Image size 2212x1659; color fundus image; FOV: 45 degrees:
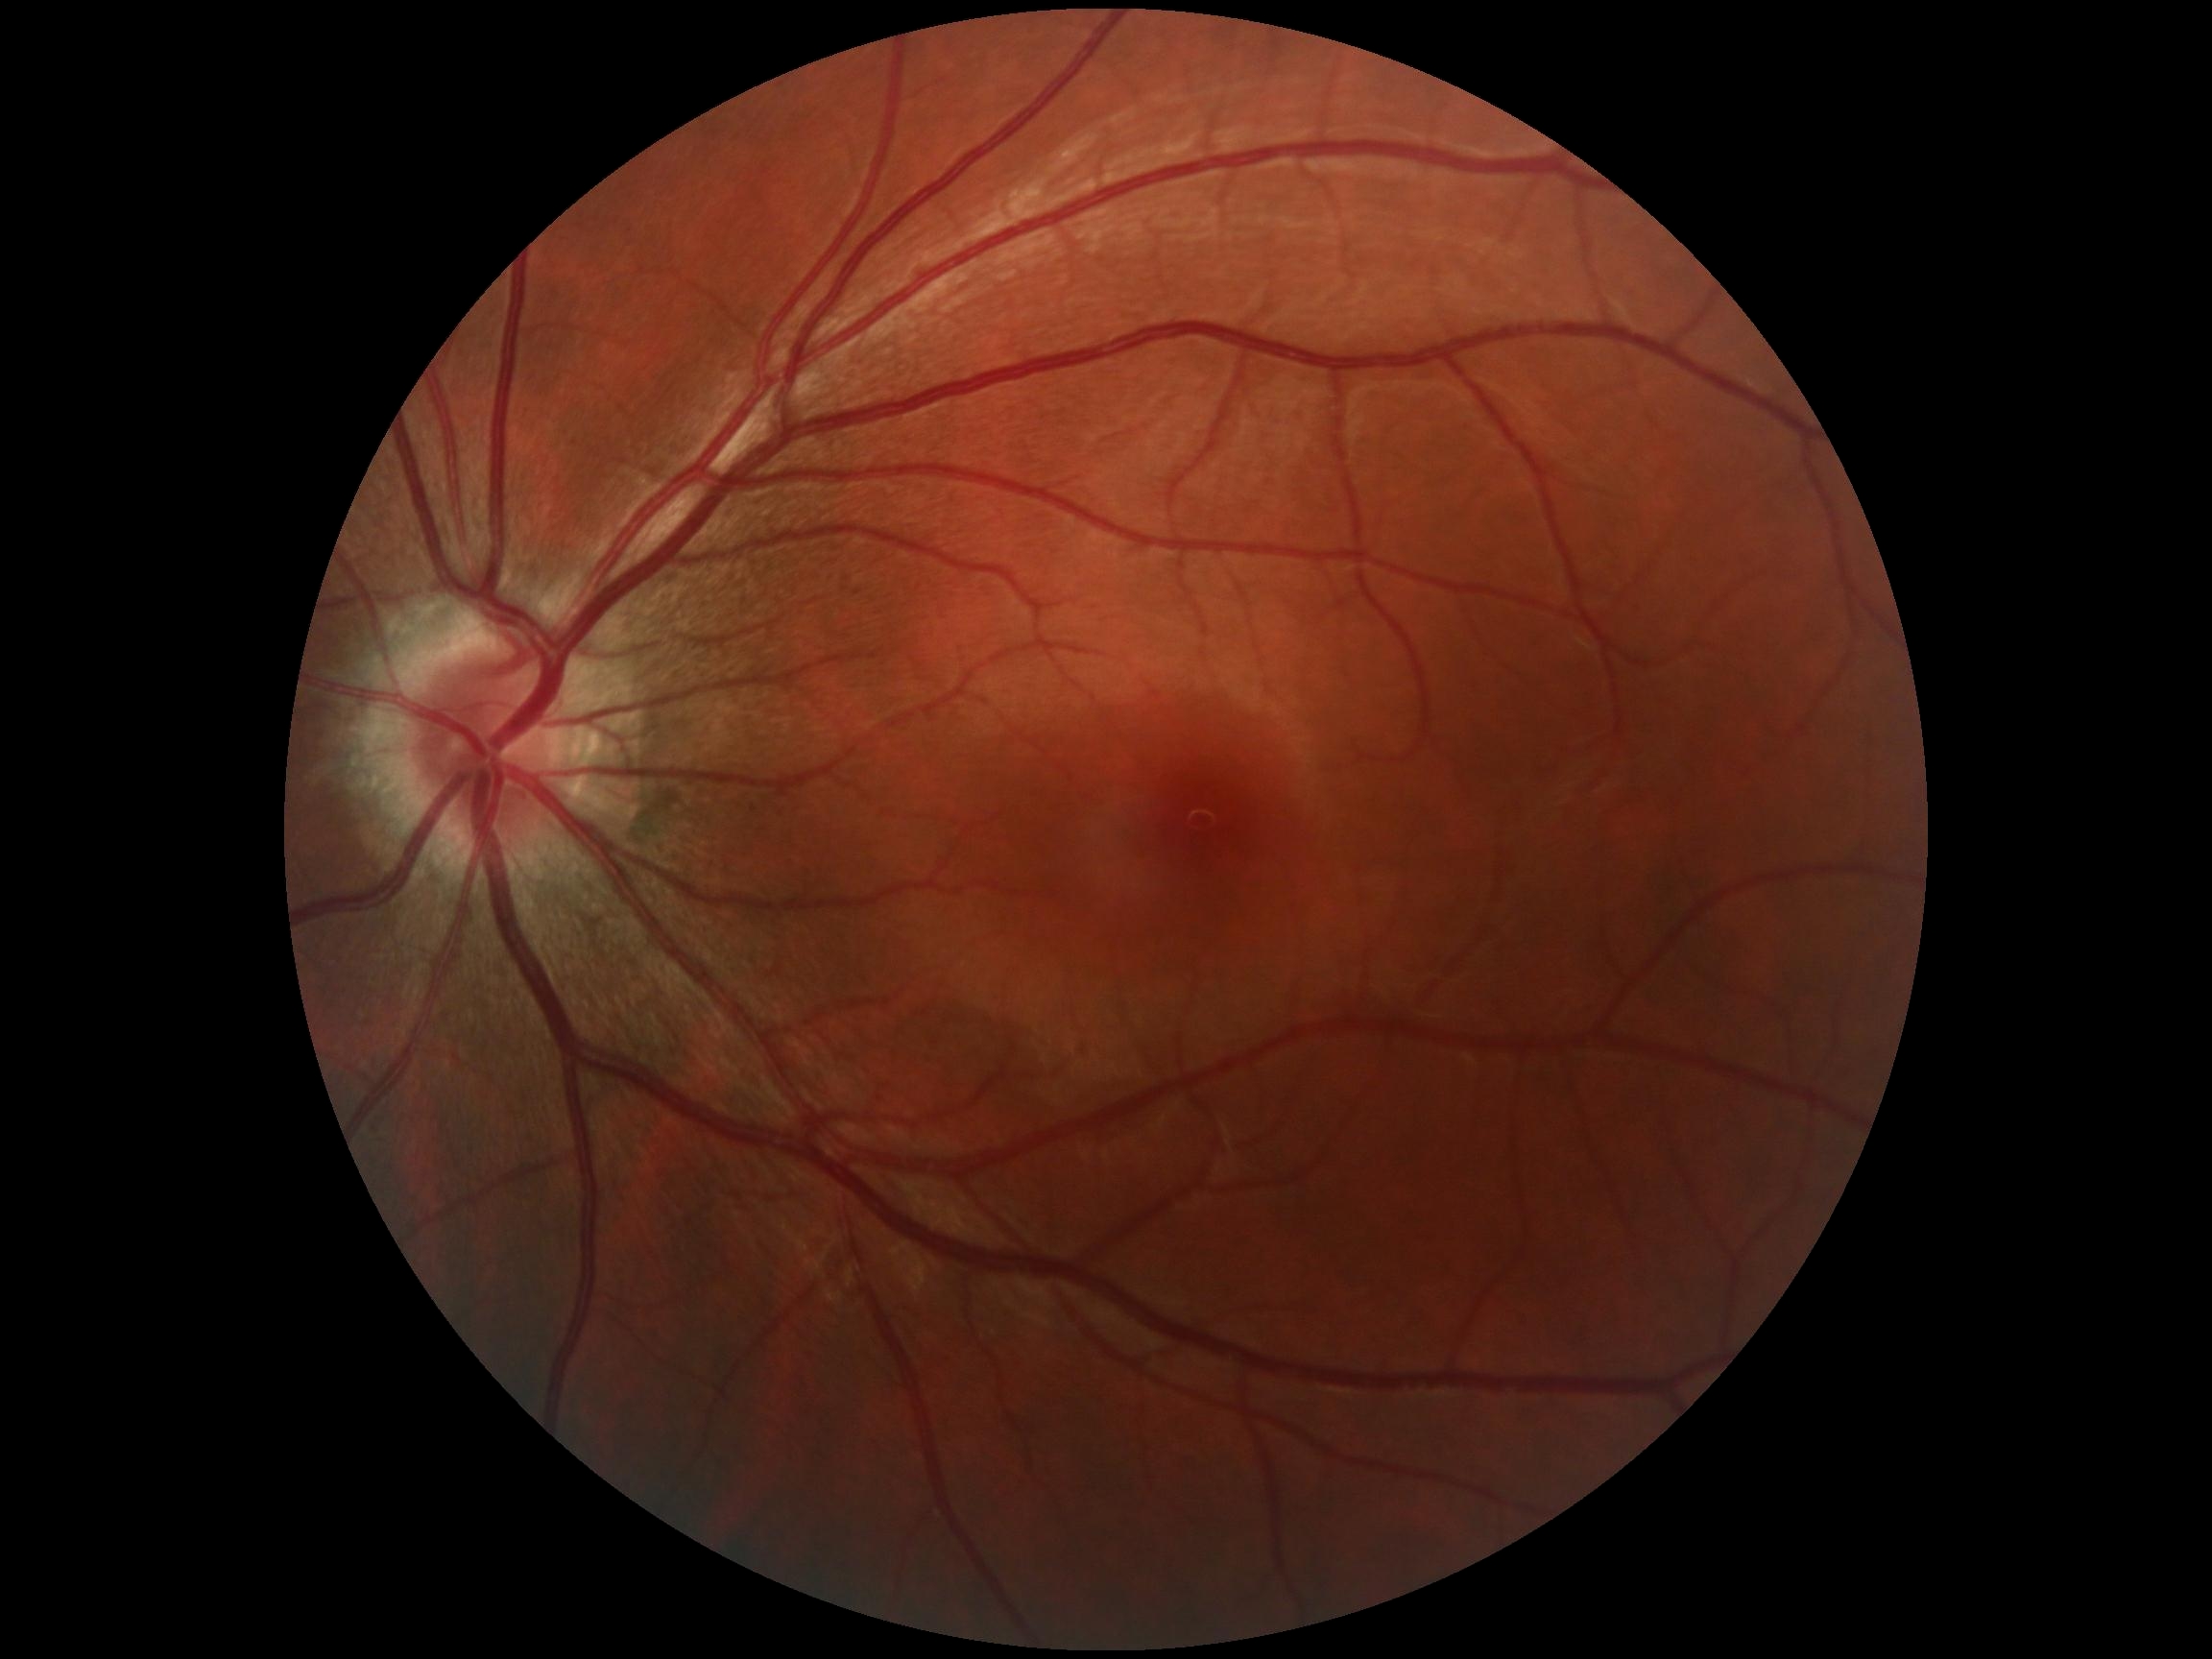

Retinopathy: no apparent retinopathy (grade 0).